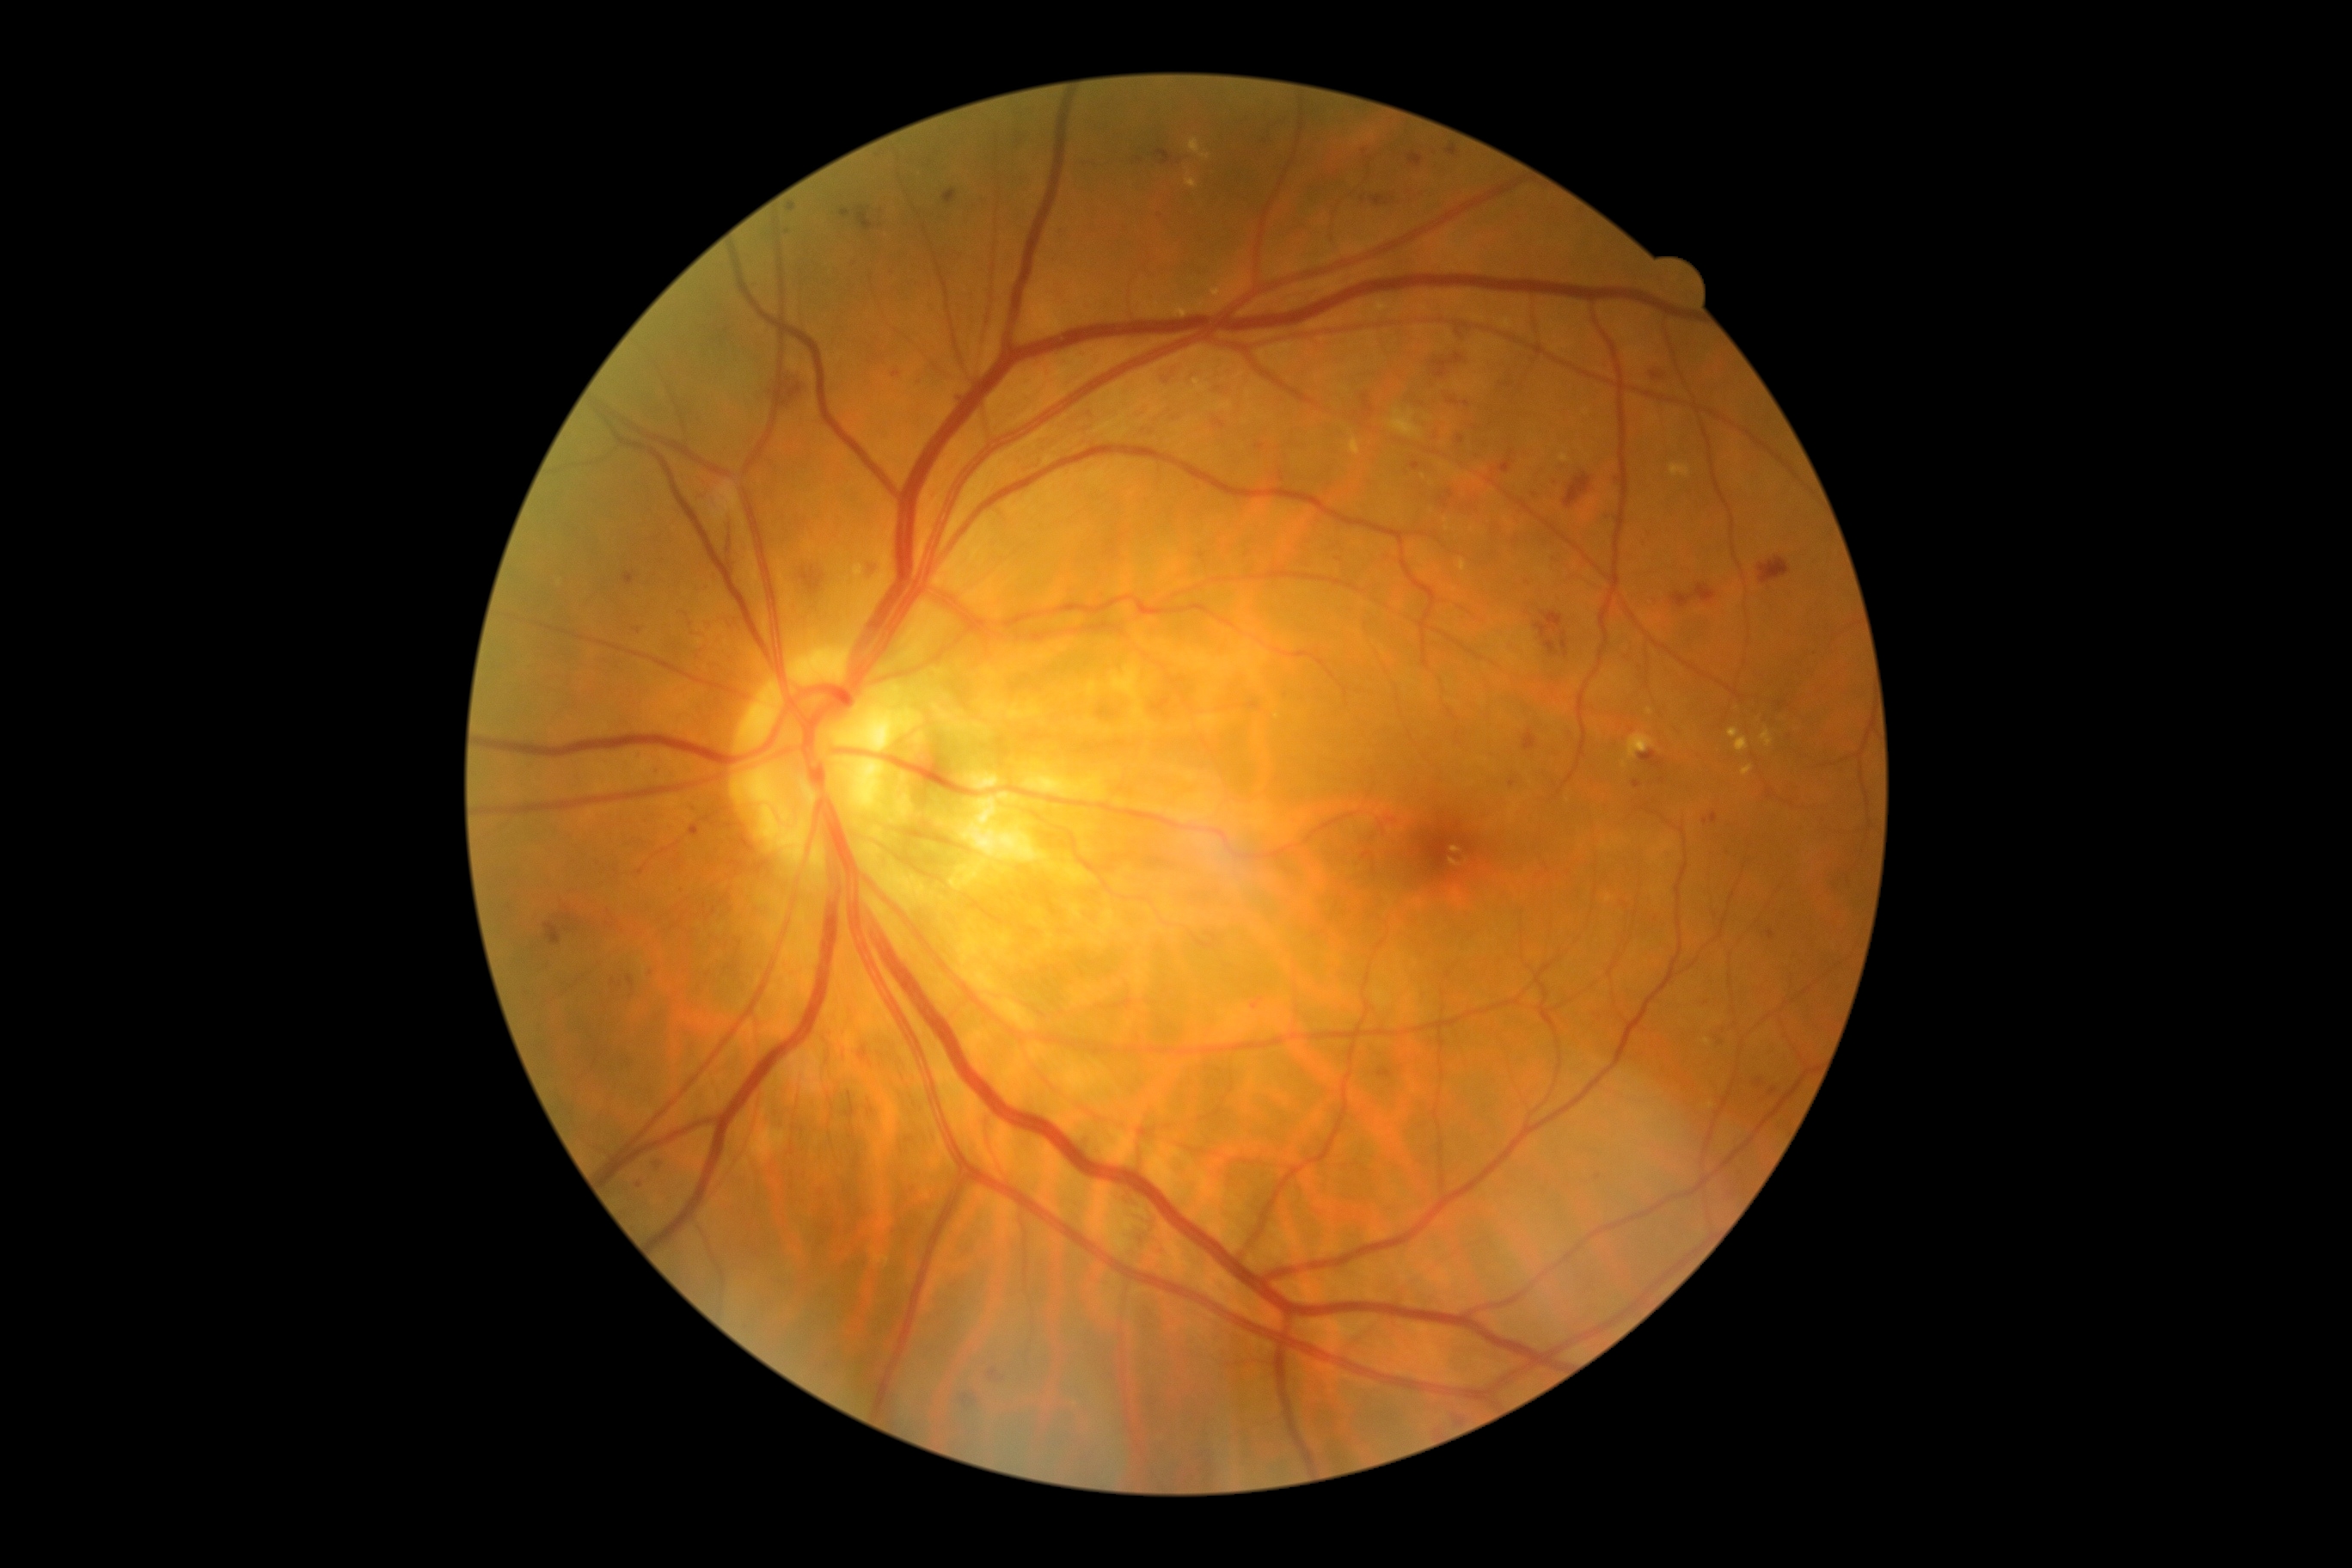

DR is grade 2 (moderate NPDR)
Selected lesions:
MAs (more not shown): [1651,371,1665,381], [855,207,874,231], [1251,998,1265,1010], [1770,1087,1777,1096], [848,260,857,267], [1440,491,1455,508], [1710,814,1718,824], [1543,640,1559,656], [1505,384,1514,388], [988,1369,998,1380], [1278,472,1285,482], [1363,149,1368,157], [1509,780,1516,788]
Smaller MAs around [x=787, y=232], [x=1370, y=159], [x=707, y=587], [x=962, y=401], [x=1599, y=1176]